Graded on the modified Davis scale.
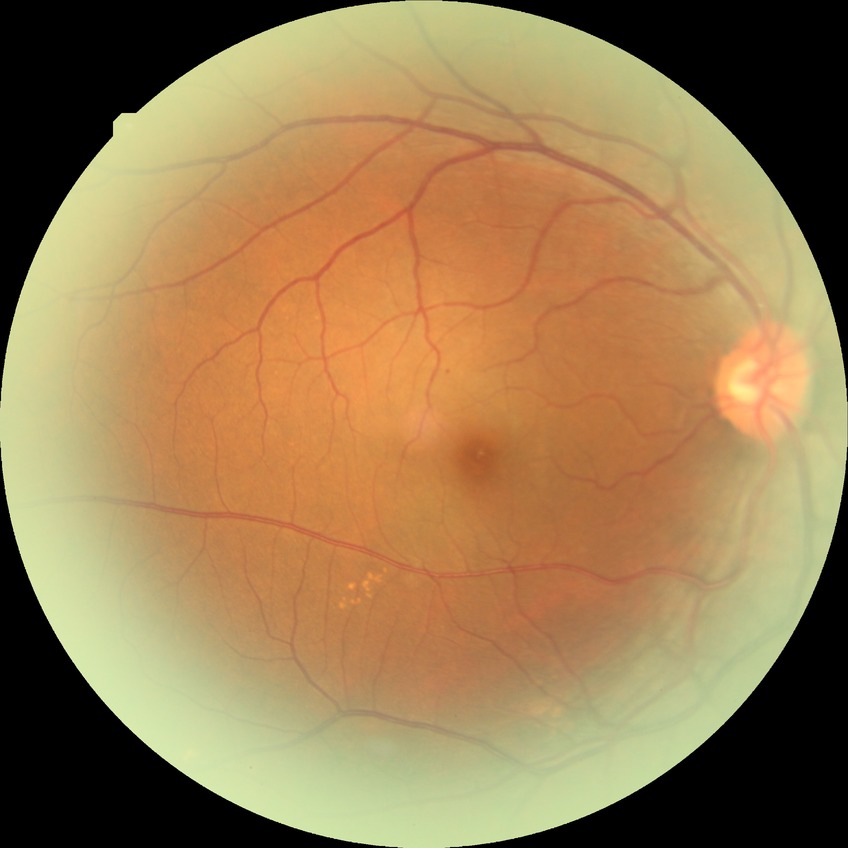
davis_grade: simple diabetic retinopathy (SDR)